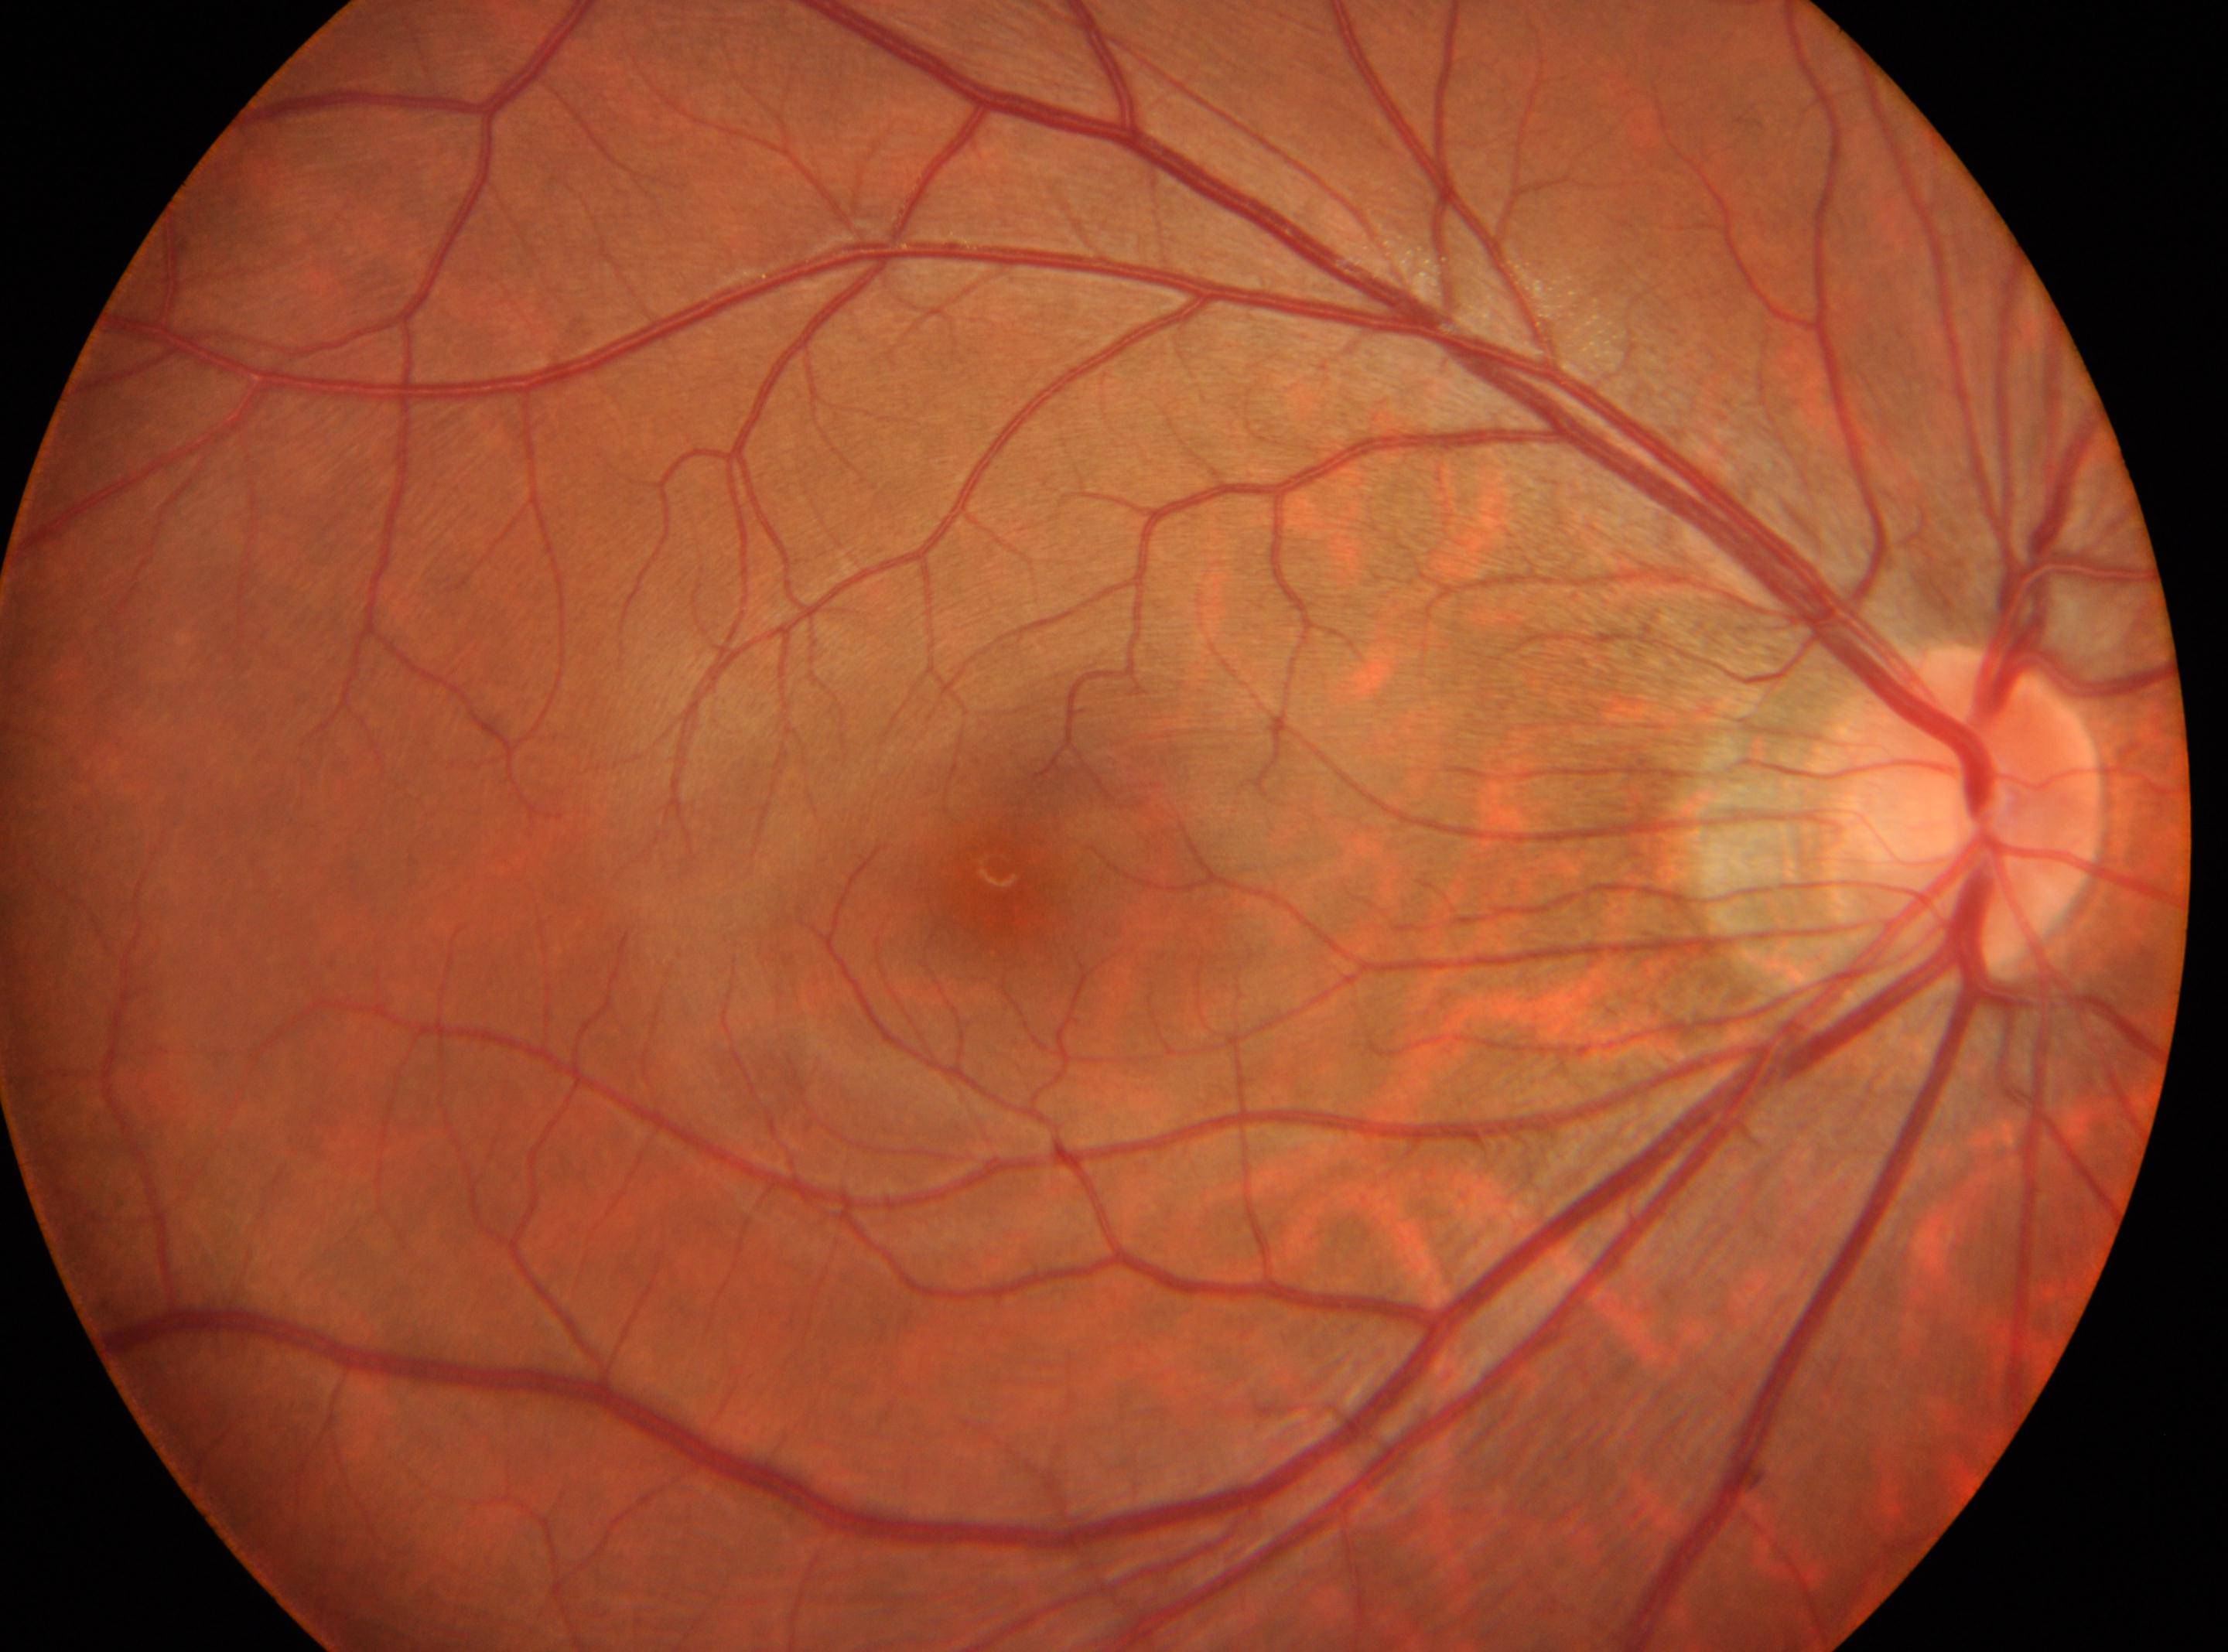 Imaged eye: oculus dexter.
Retinopathy grade: 0.
Fovea center: 998px, 869px.
Optic nerve head located at 1960px, 811px.